45° field of view · 2352 x 1568 pixels:
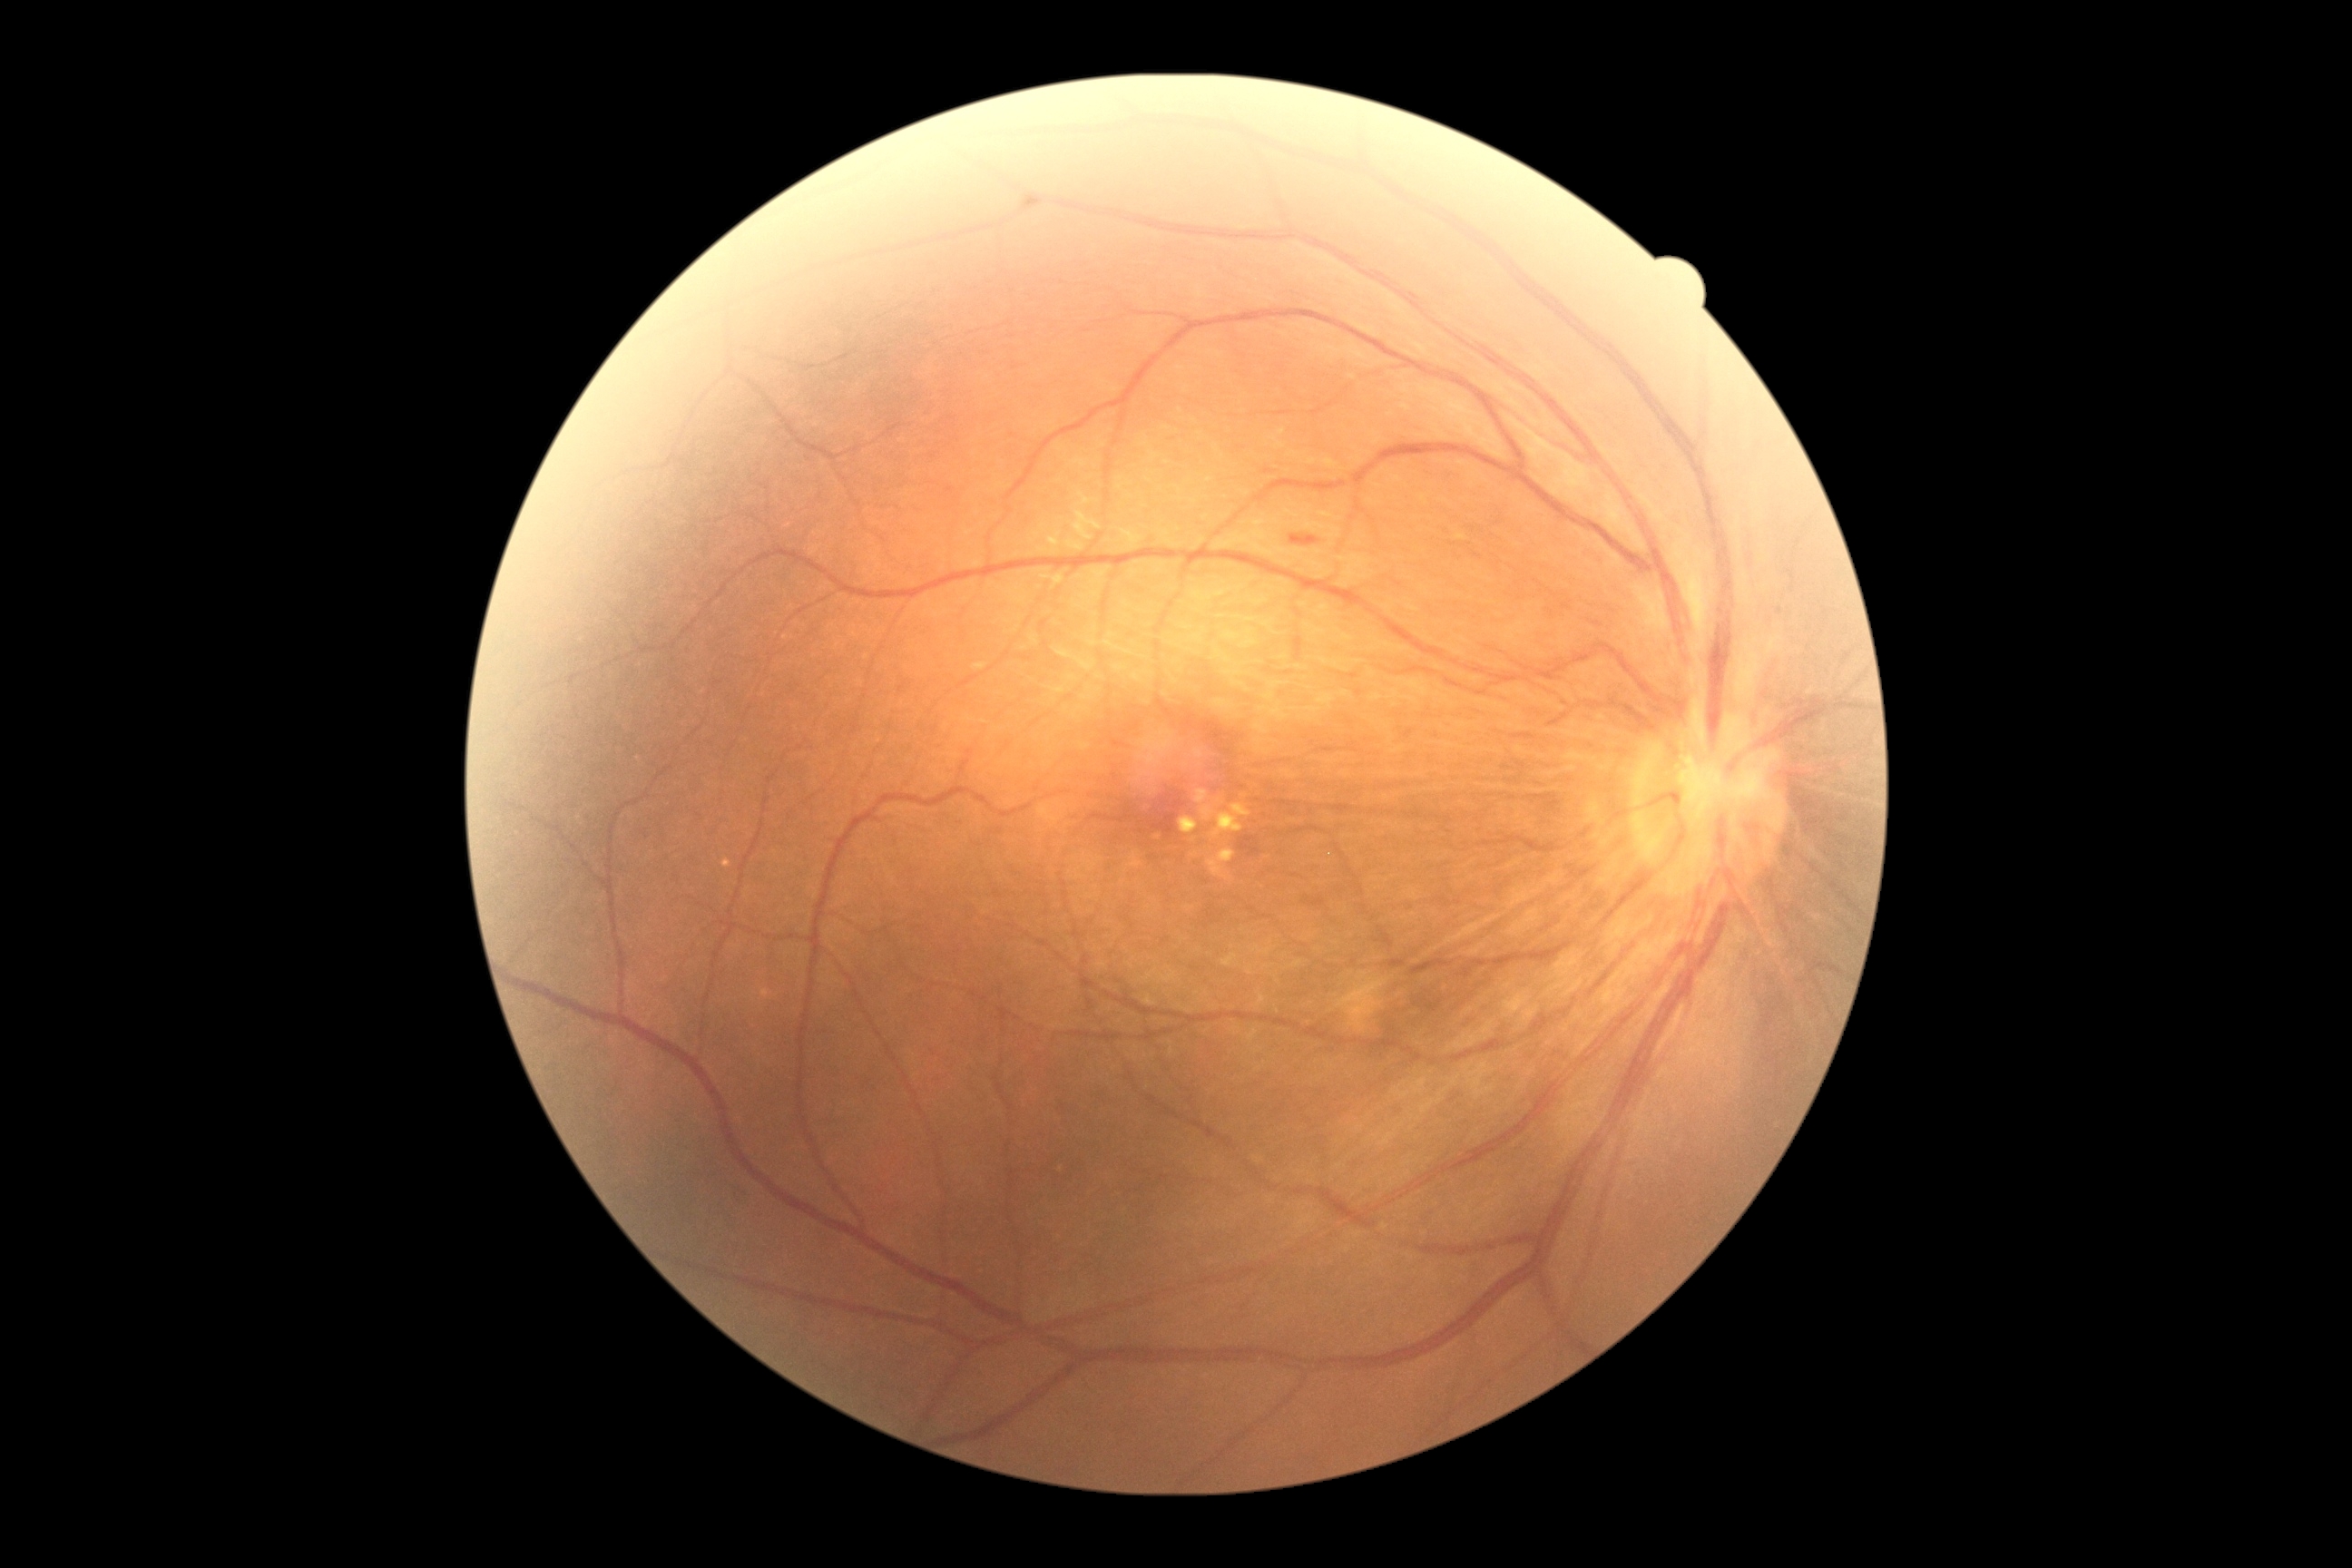
DR@2/4.